Without pupil dilation, image size 848x848, modified Davis classification, posterior pole color fundus photograph: 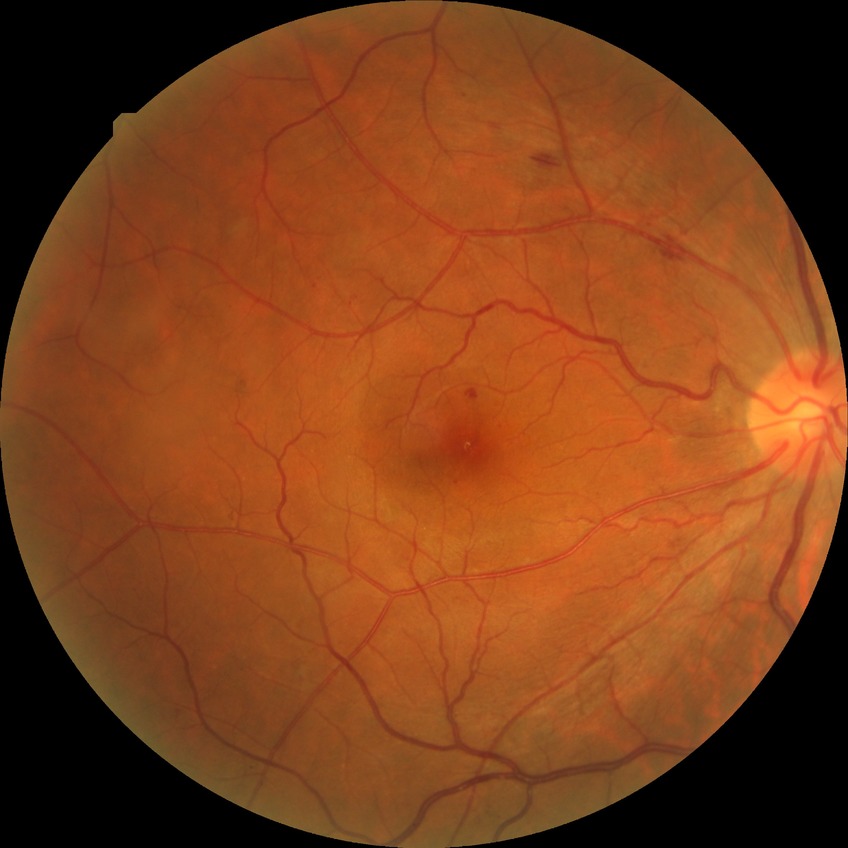

diabetic retinopathy (DR) = SDR (simple diabetic retinopathy)